Fundus photograph cropped around the optic nerve head, Topcon TRC retinal camera, IMAGEnet capture system.
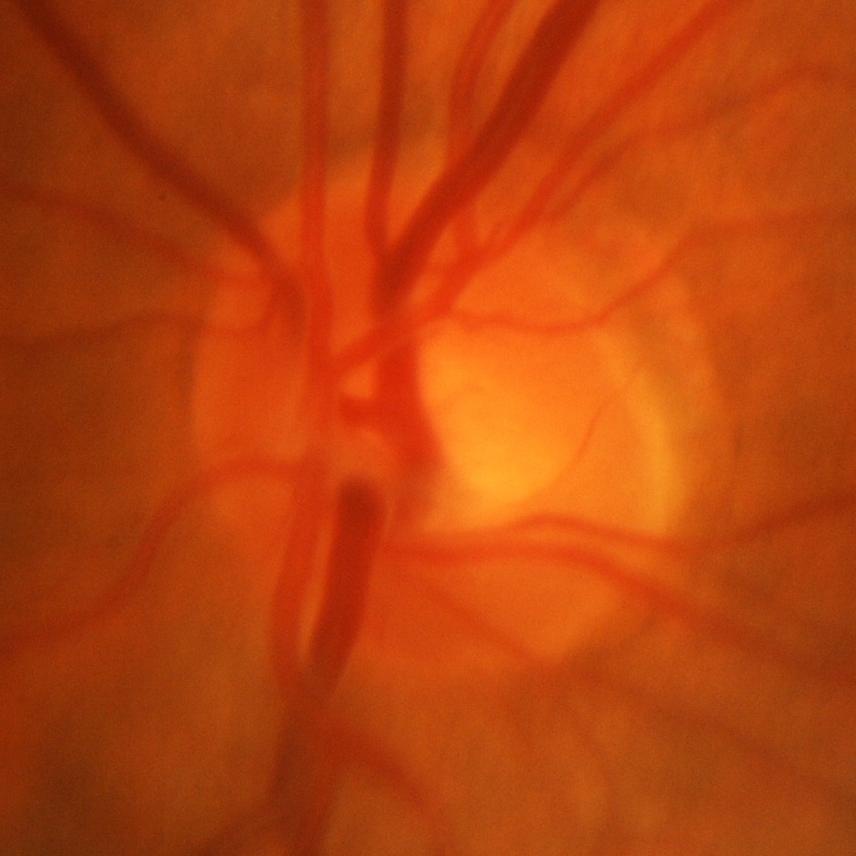 Evidence of glaucoma.